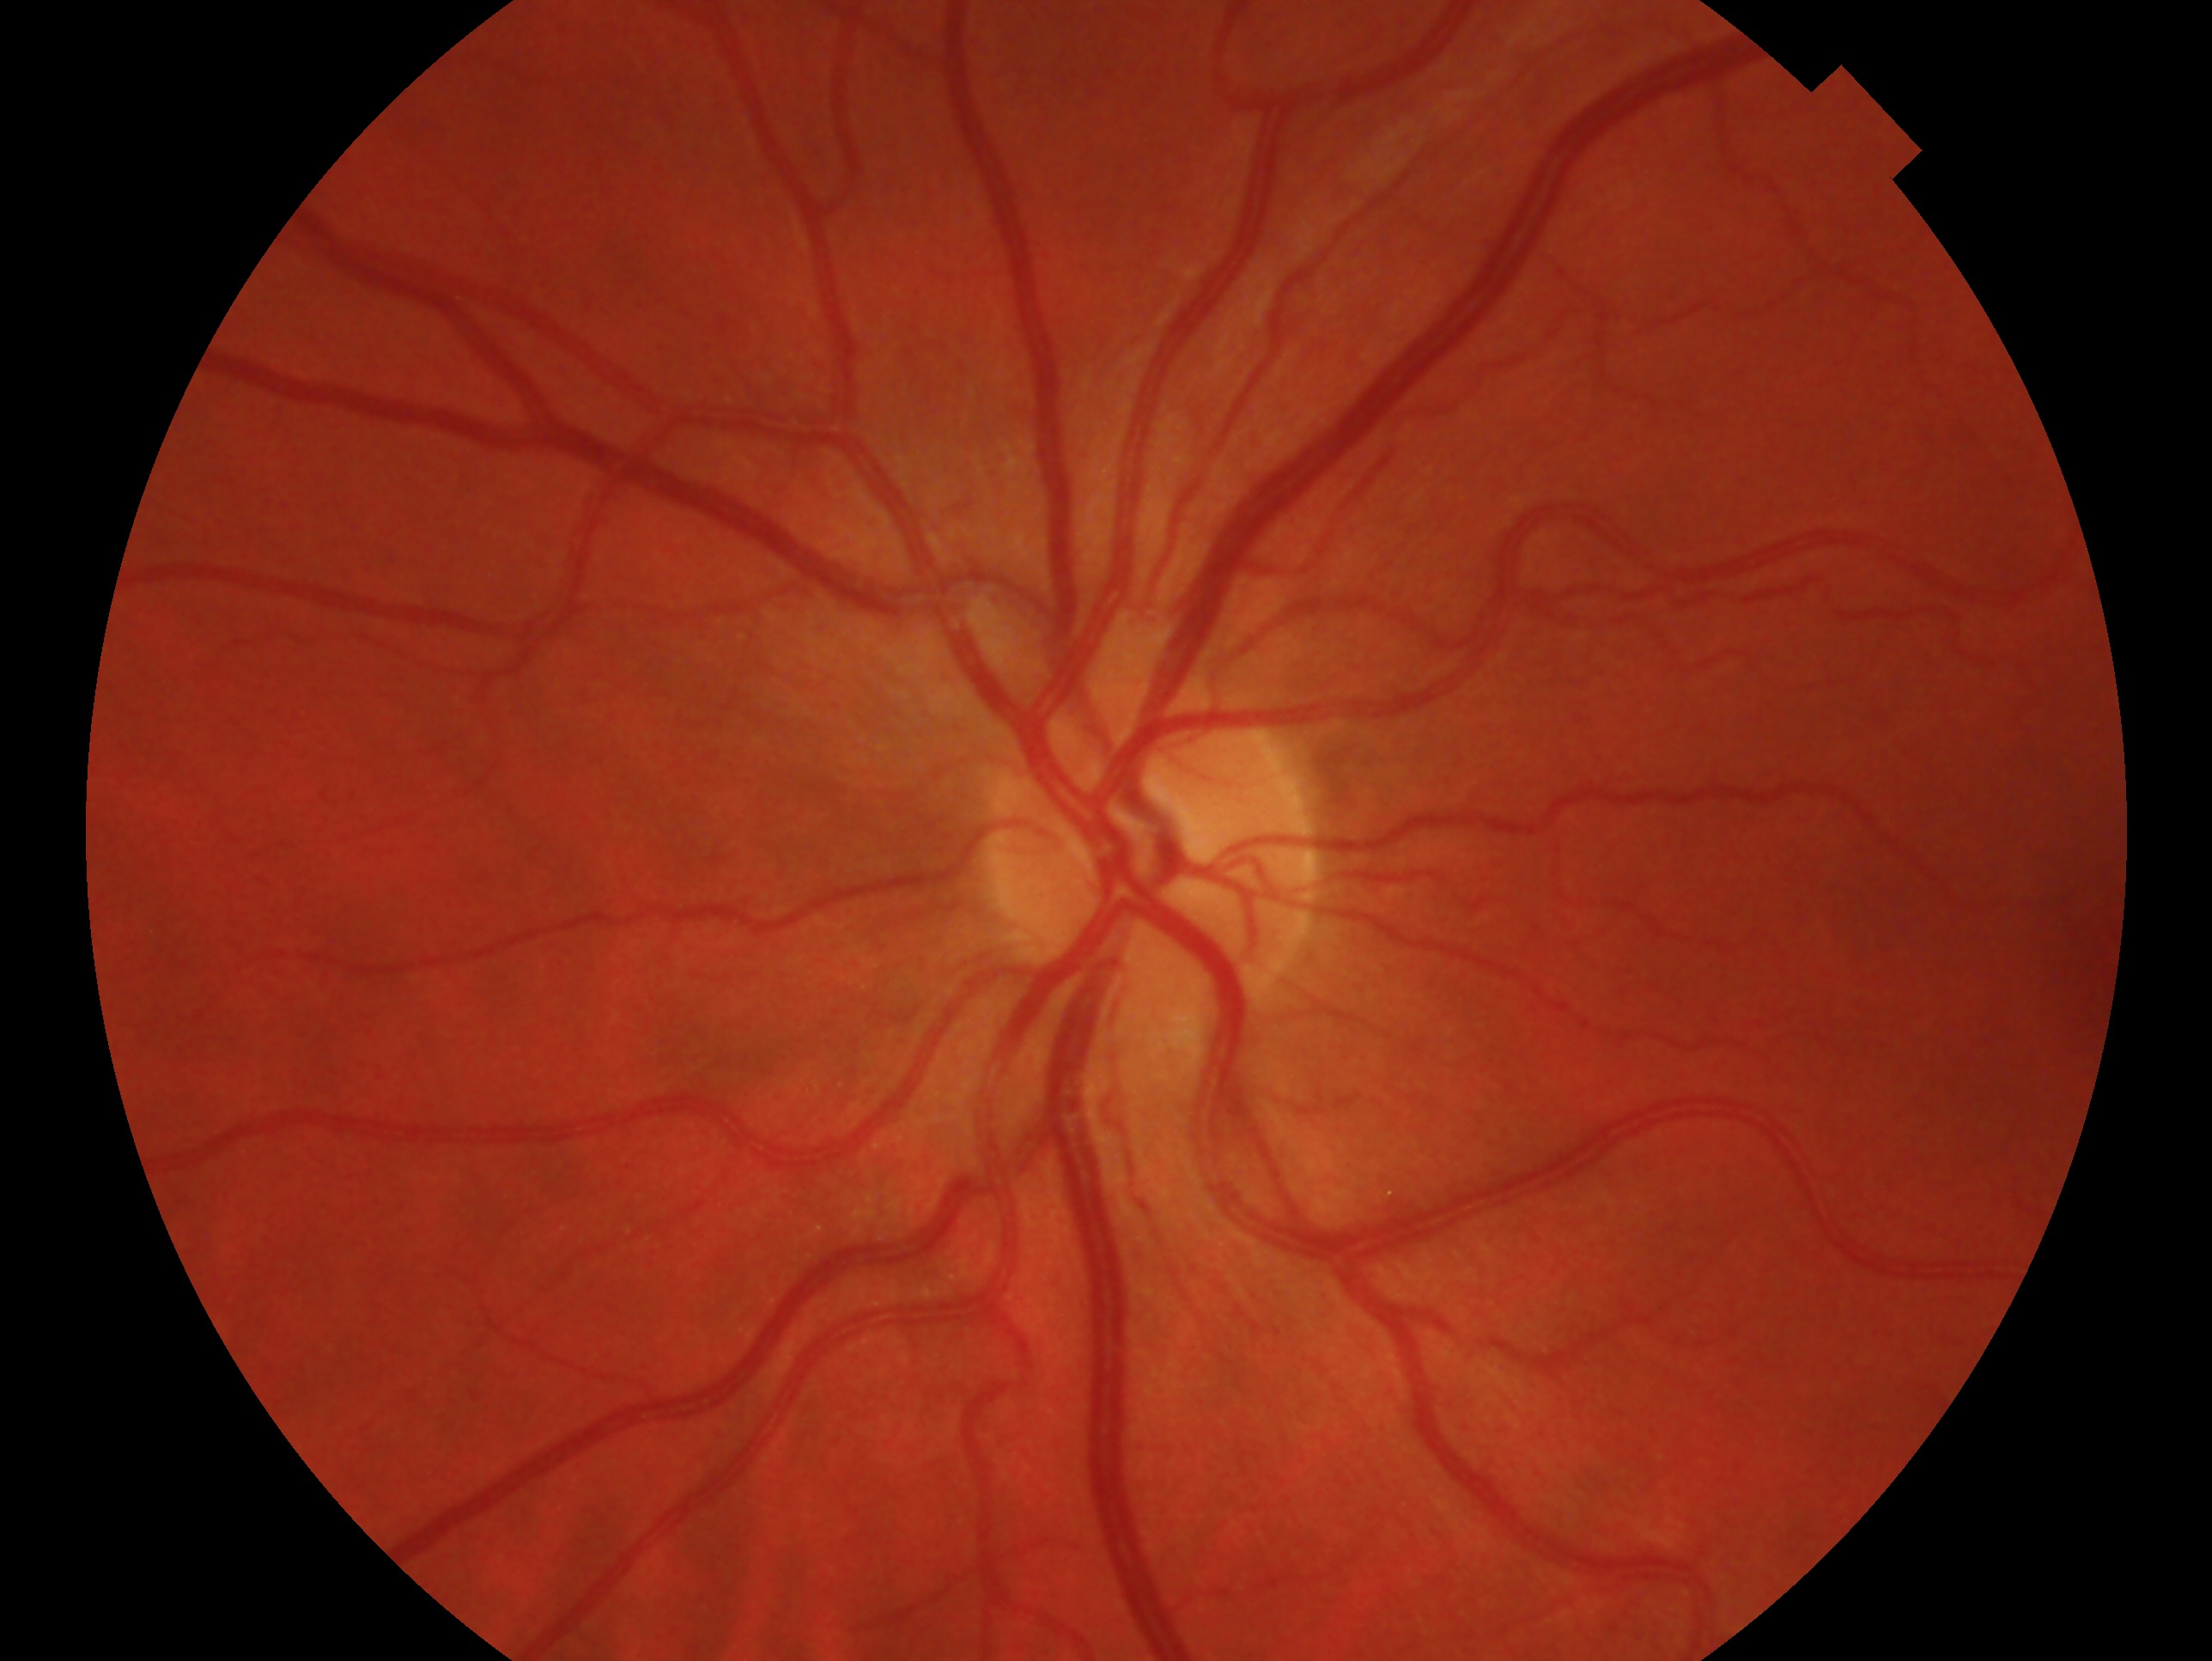
Findings:
* glaucoma status · no glaucoma
* laterality · left eye